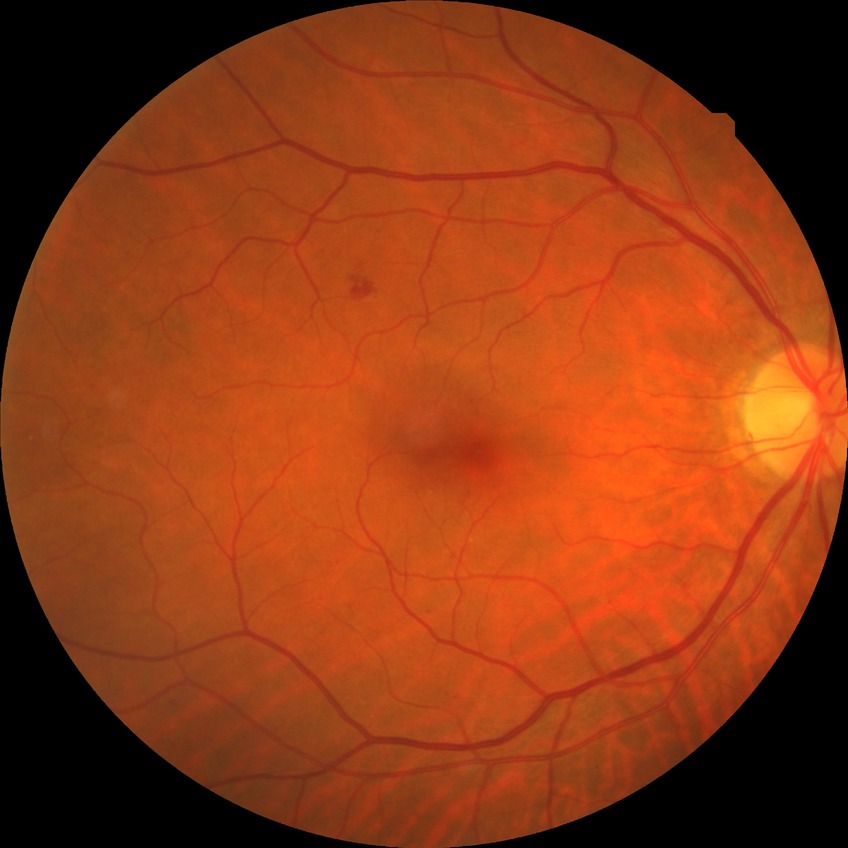

modified Davis classification: simple diabetic retinopathy.